Modified Davis grading; NIDEK AFC-230 fundus camera; no pharmacologic dilation.
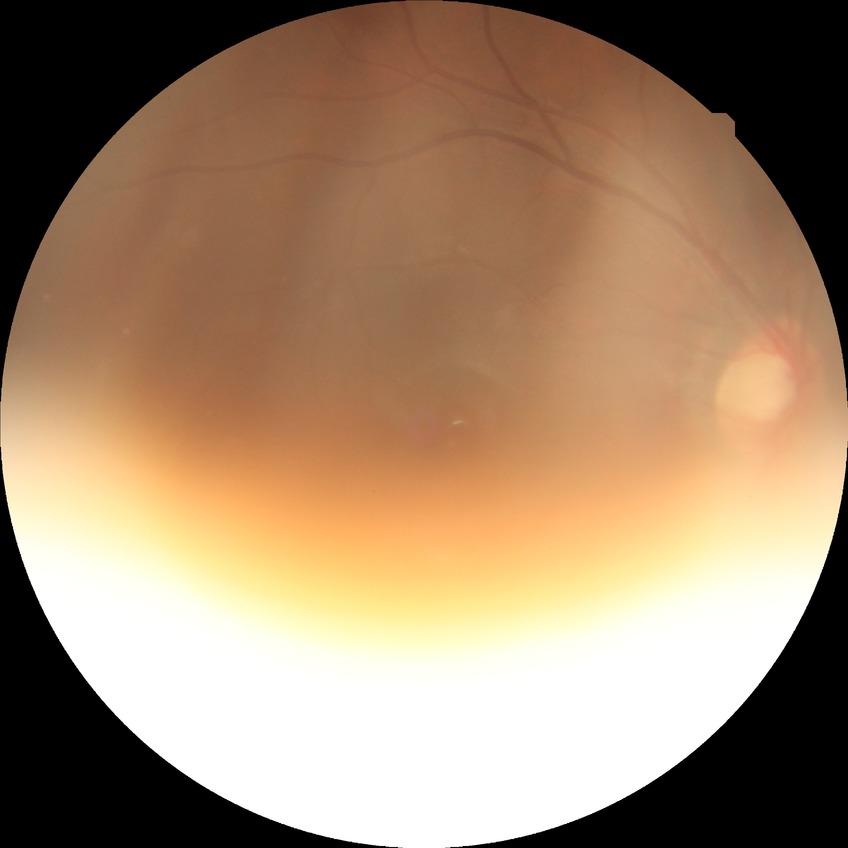 modified Davis classification = no diabetic retinopathy.